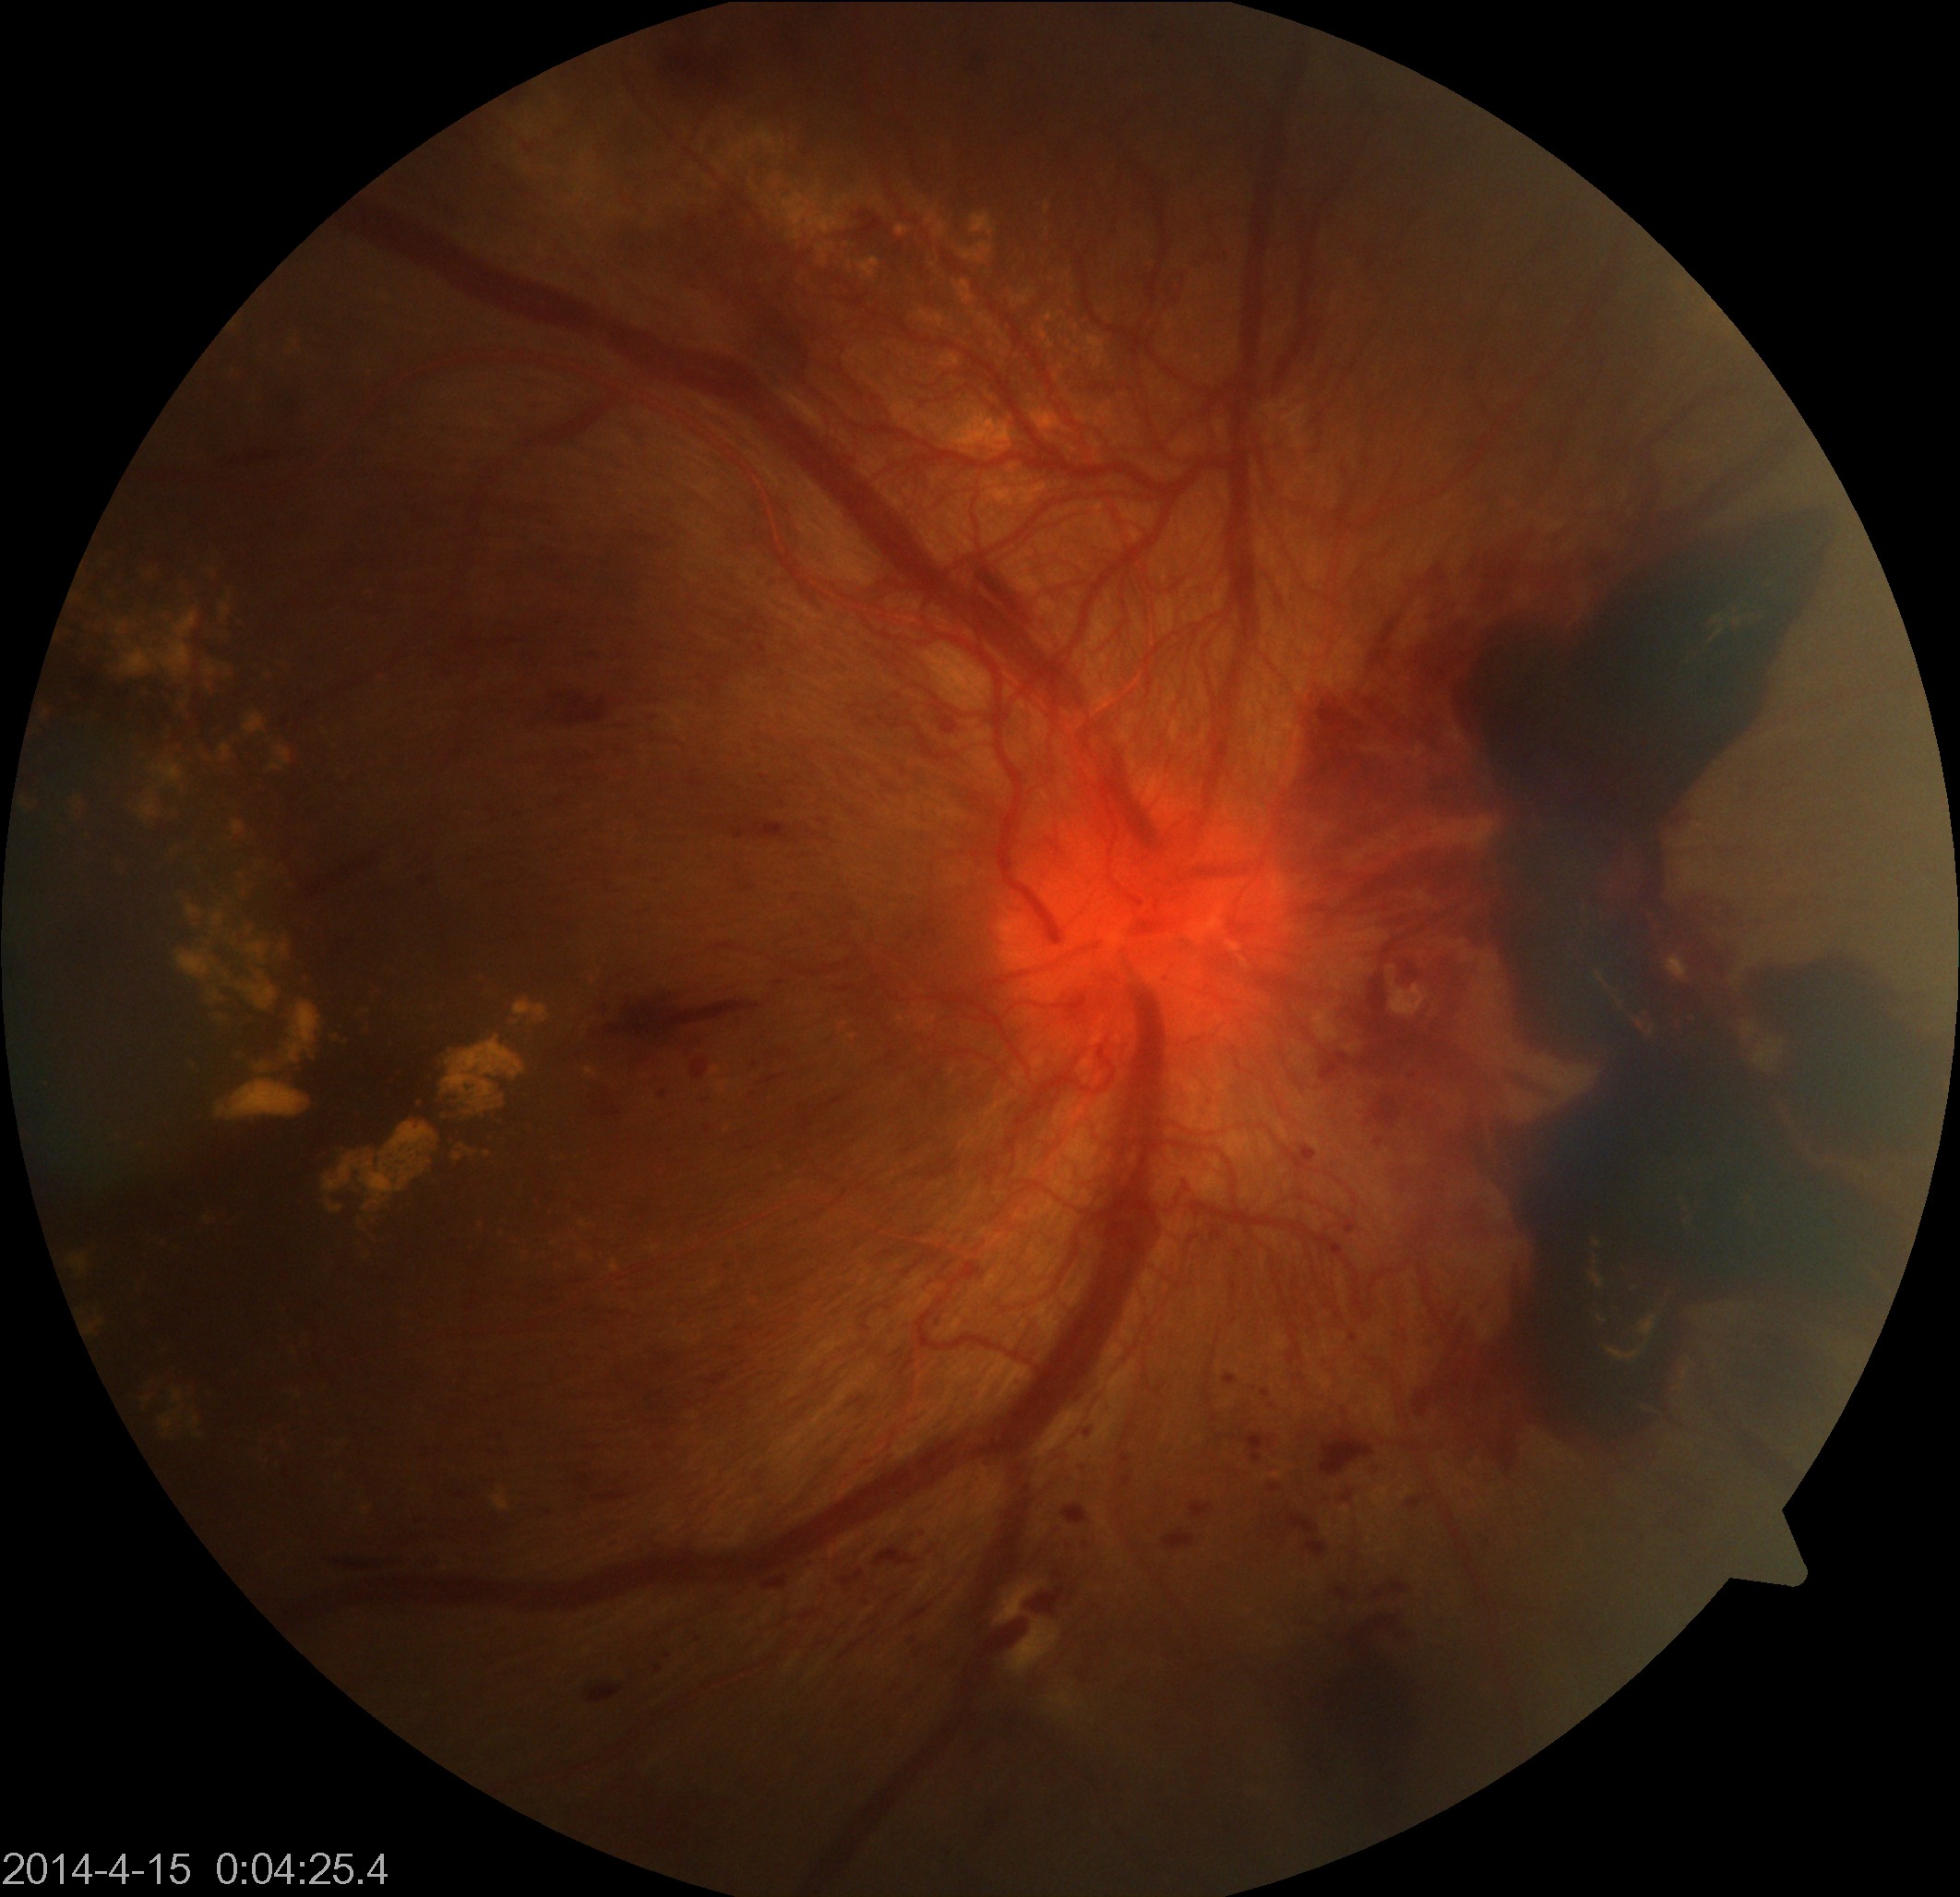

This fundus photograph shows severe non-proliferative or proliferative diabetic retinopathy. Features include severe non-proliferative diabetic retinopathy or proliferative diabetic retinopathy with neovascularization or vitreous/preretinal hemorrhage.